45° field of view: 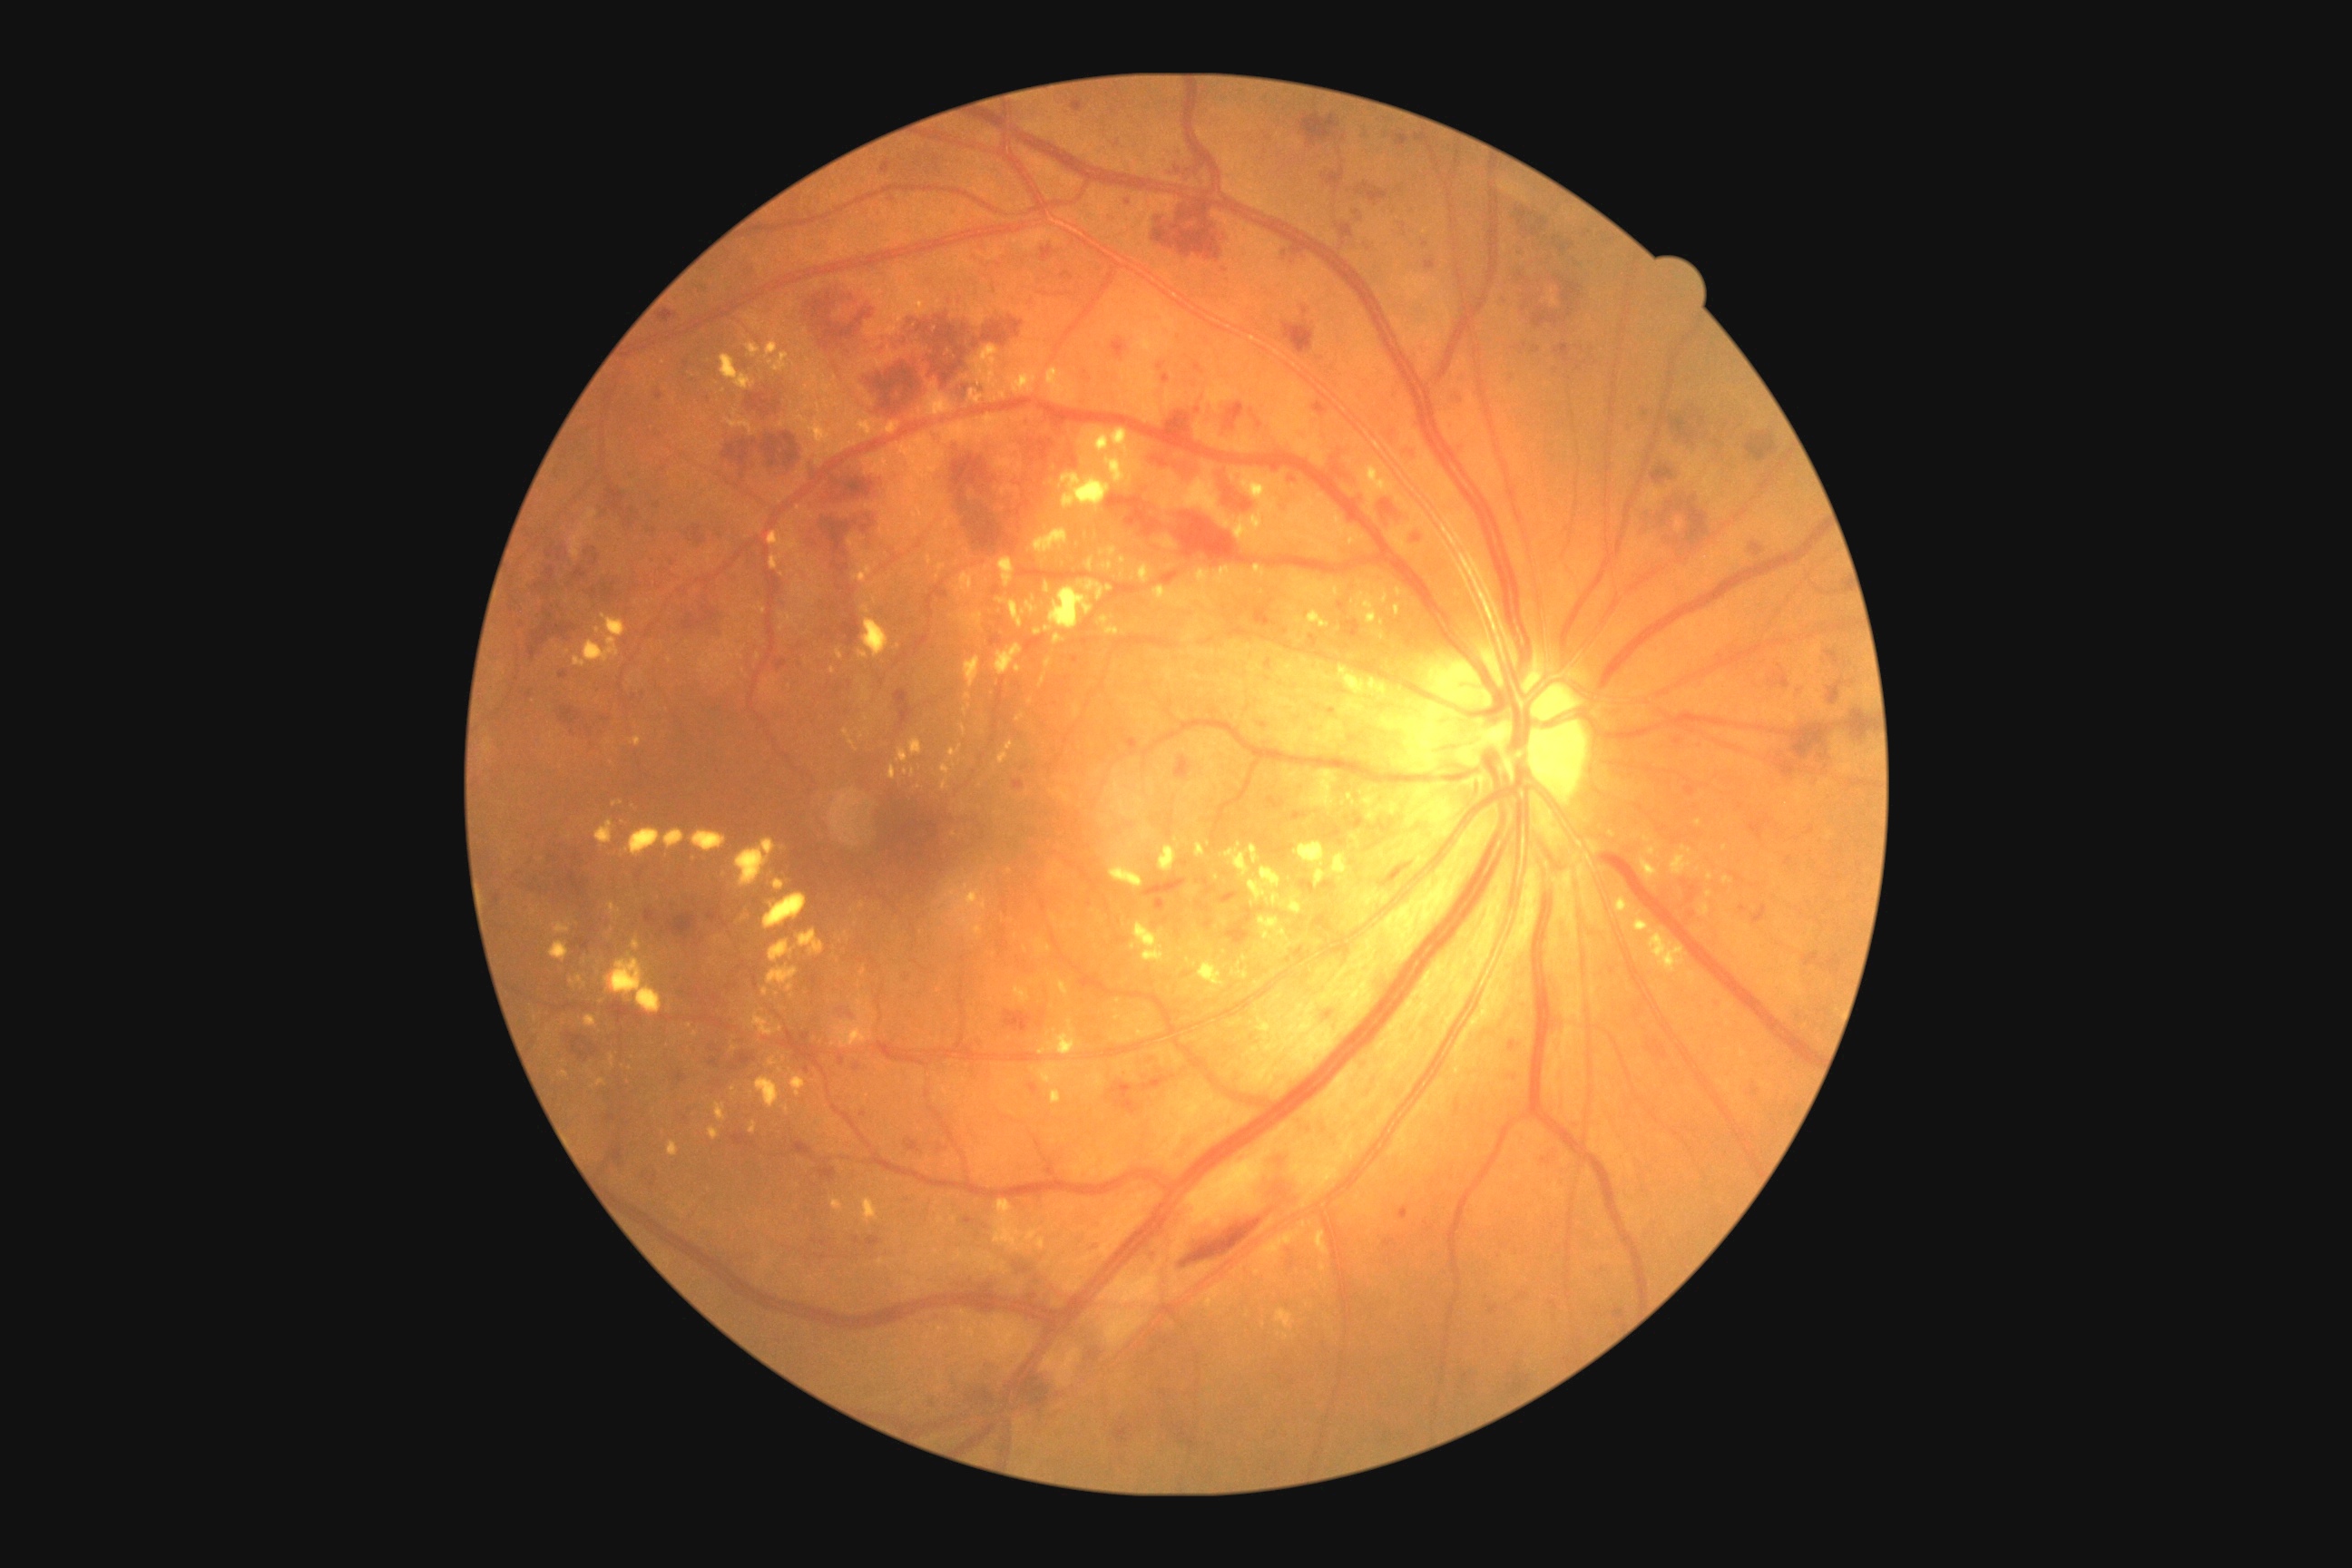

<lesions partial="true">
  <dr_grade>3</dr_grade>
  <ex partial="true">bbox=[863, 620, 890, 658]; bbox=[910, 740, 923, 756]; bbox=[1616, 901, 1629, 908]; bbox=[574, 614, 627, 669]; bbox=[1360, 460, 1396, 507]; bbox=[965, 658, 981, 689]; bbox=[1231, 970, 1248, 981]; bbox=[560, 1070, 569, 1077]; bbox=[765, 340, 779, 366]; bbox=[776, 420, 787, 429]; bbox=[611, 1054, 614, 1068]; bbox=[1006, 369, 1037, 395]; bbox=[1153, 585, 1168, 605]; bbox=[1026, 602, 1037, 614]</ex>
  <ex_small_centers>(x=735, y=1049); (x=993, y=400); (x=723, y=391); (x=833, y=672); (x=866, y=730)</ex_small_centers>
</lesions>